CFP; 45-degree field of view; image size 1932x1910 — 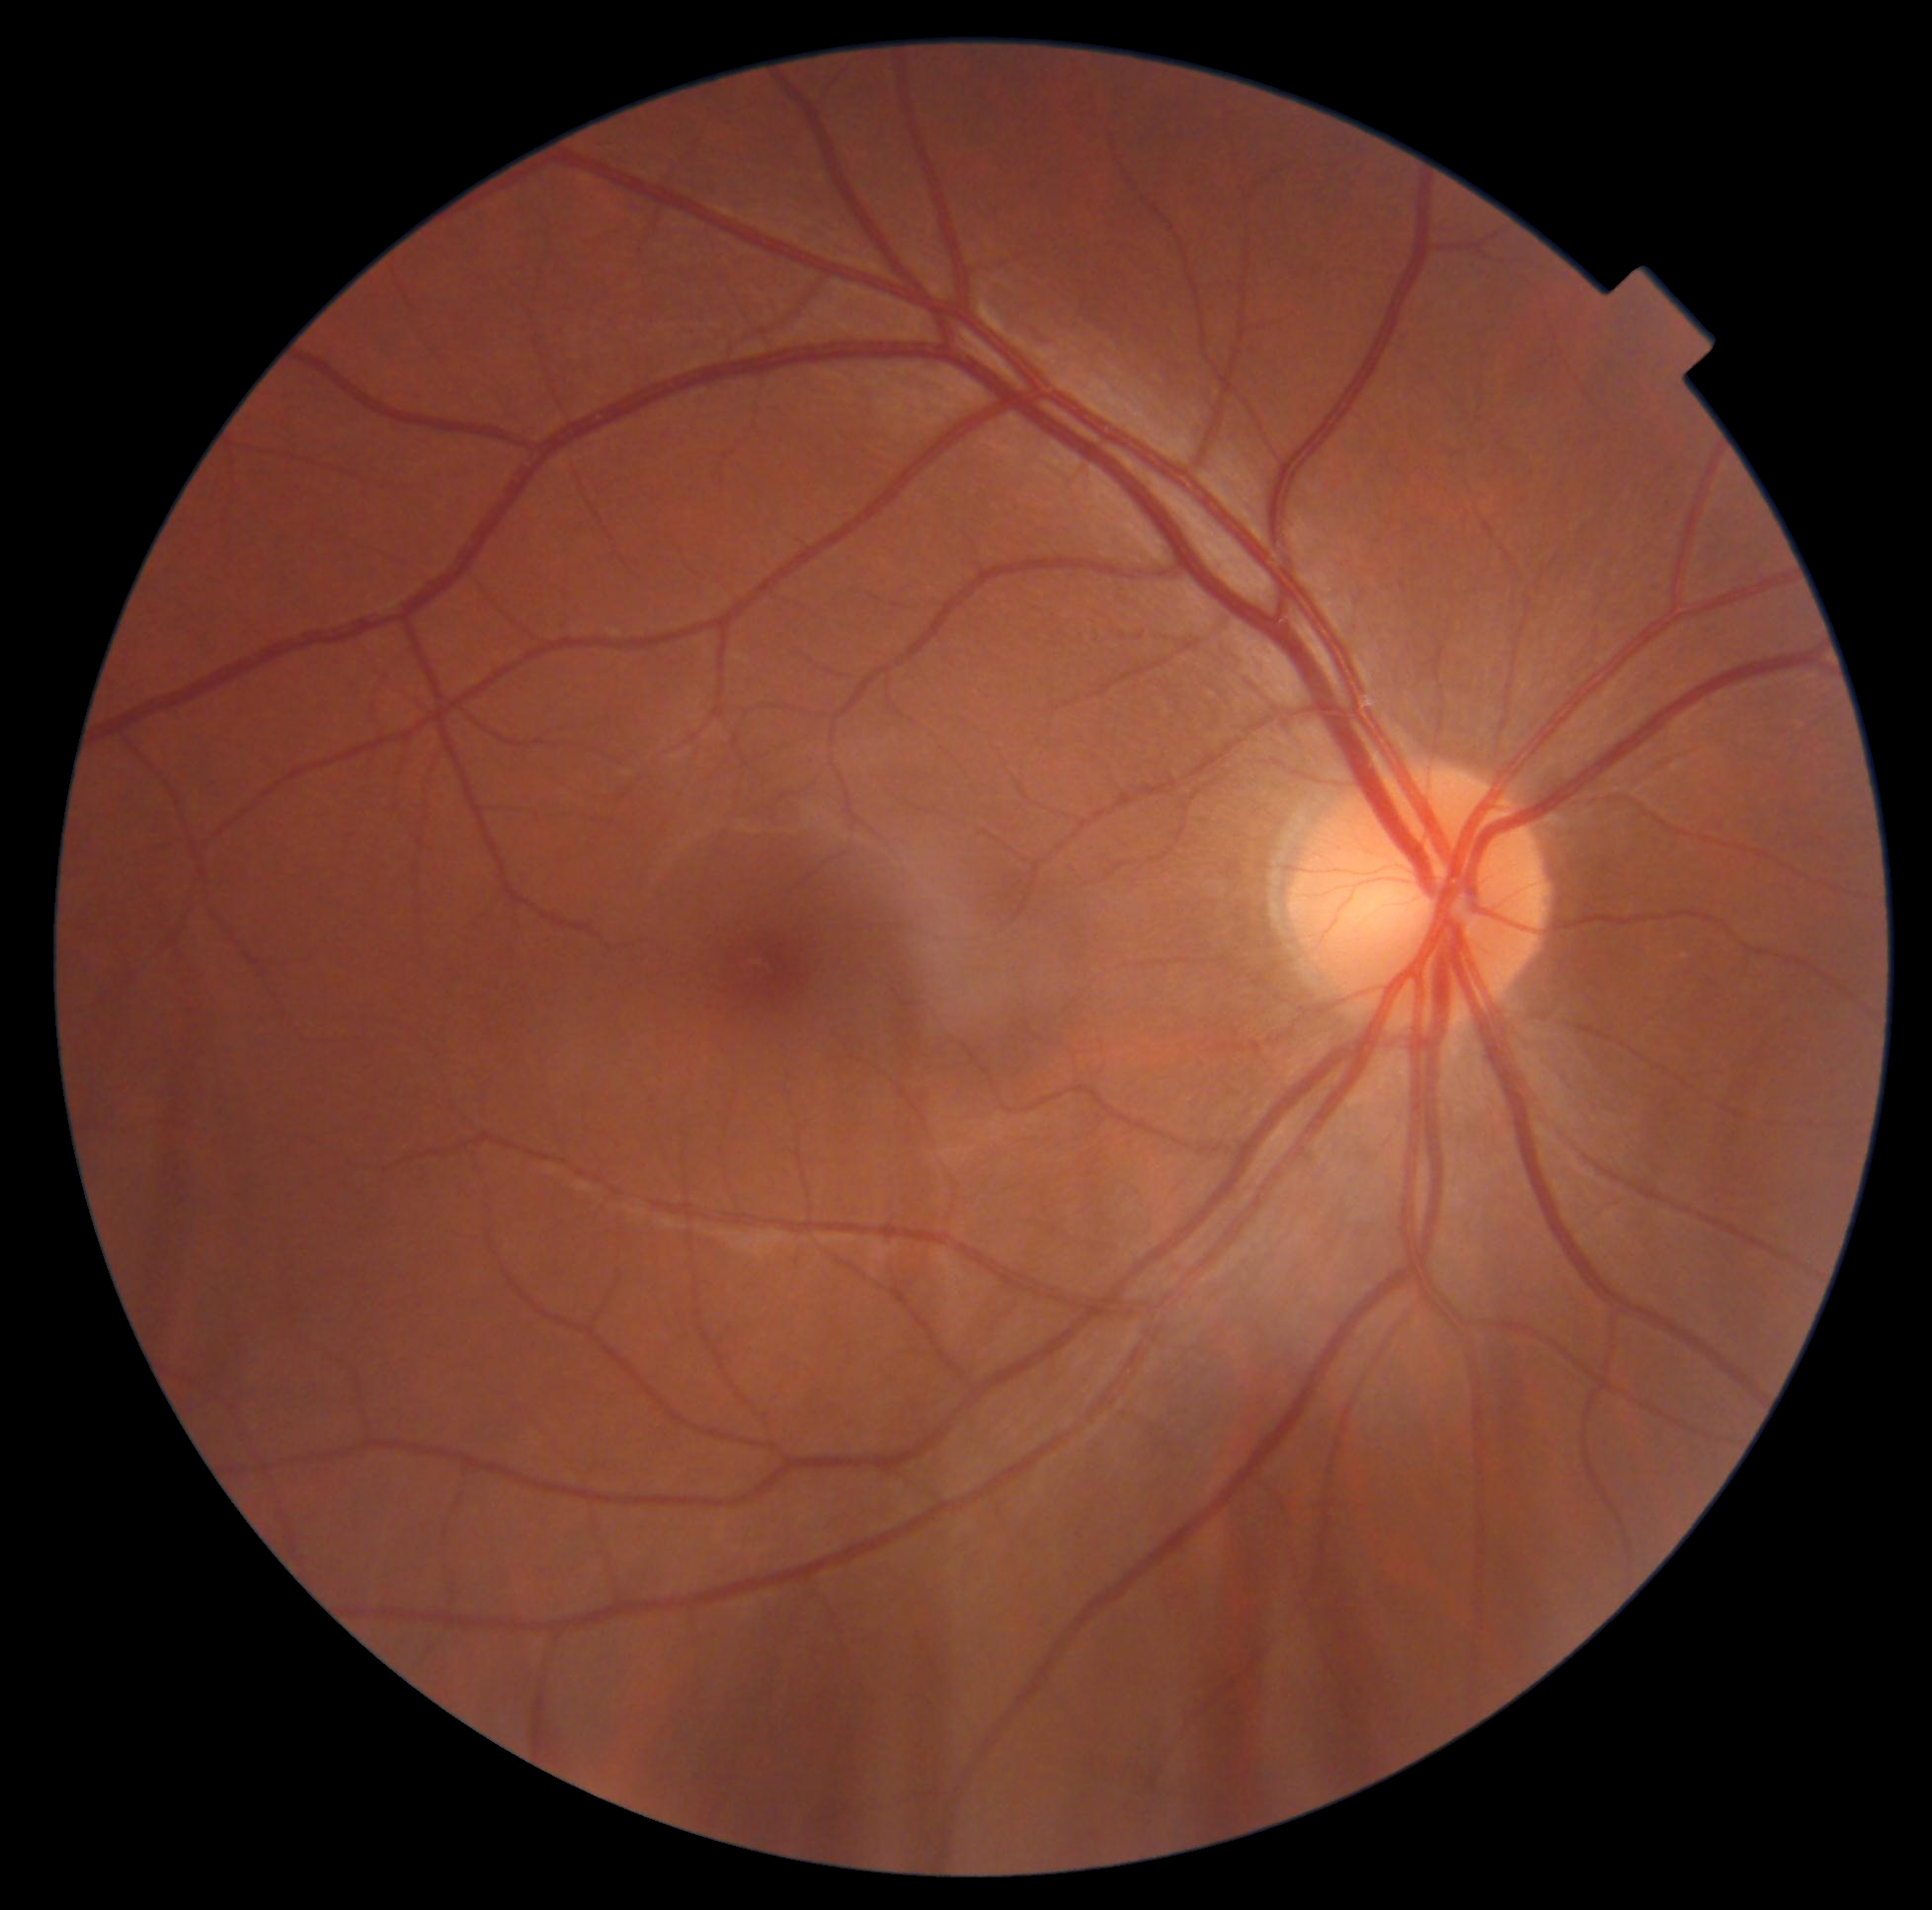
Findings:
* DR grade: 0